848x848. CFP.
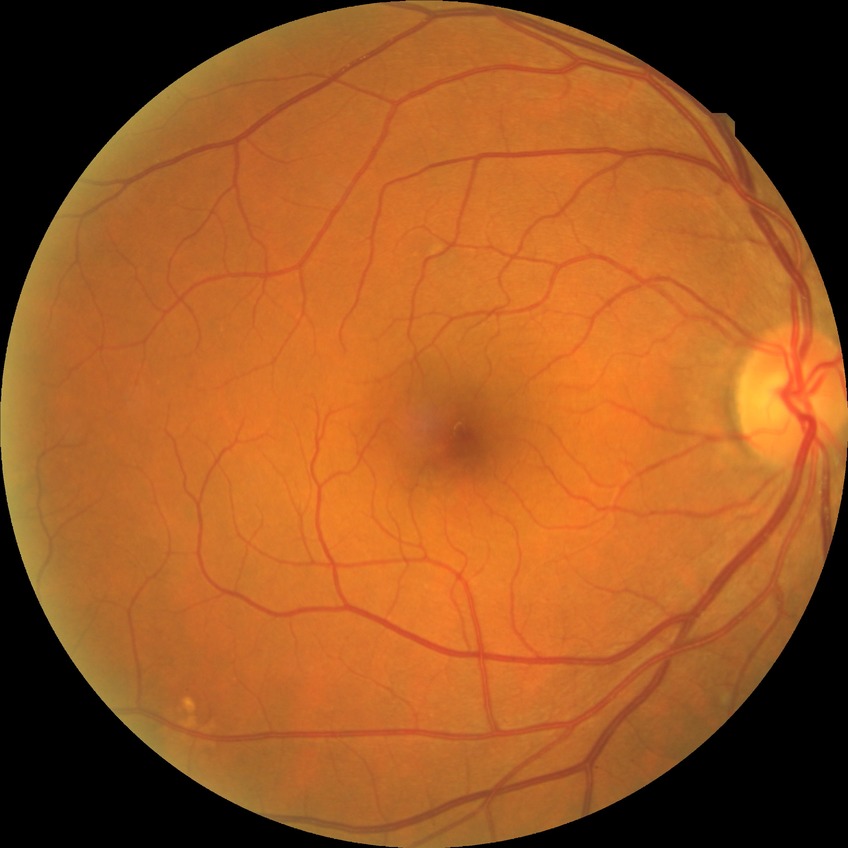
  davis_grade: simple diabetic retinopathy